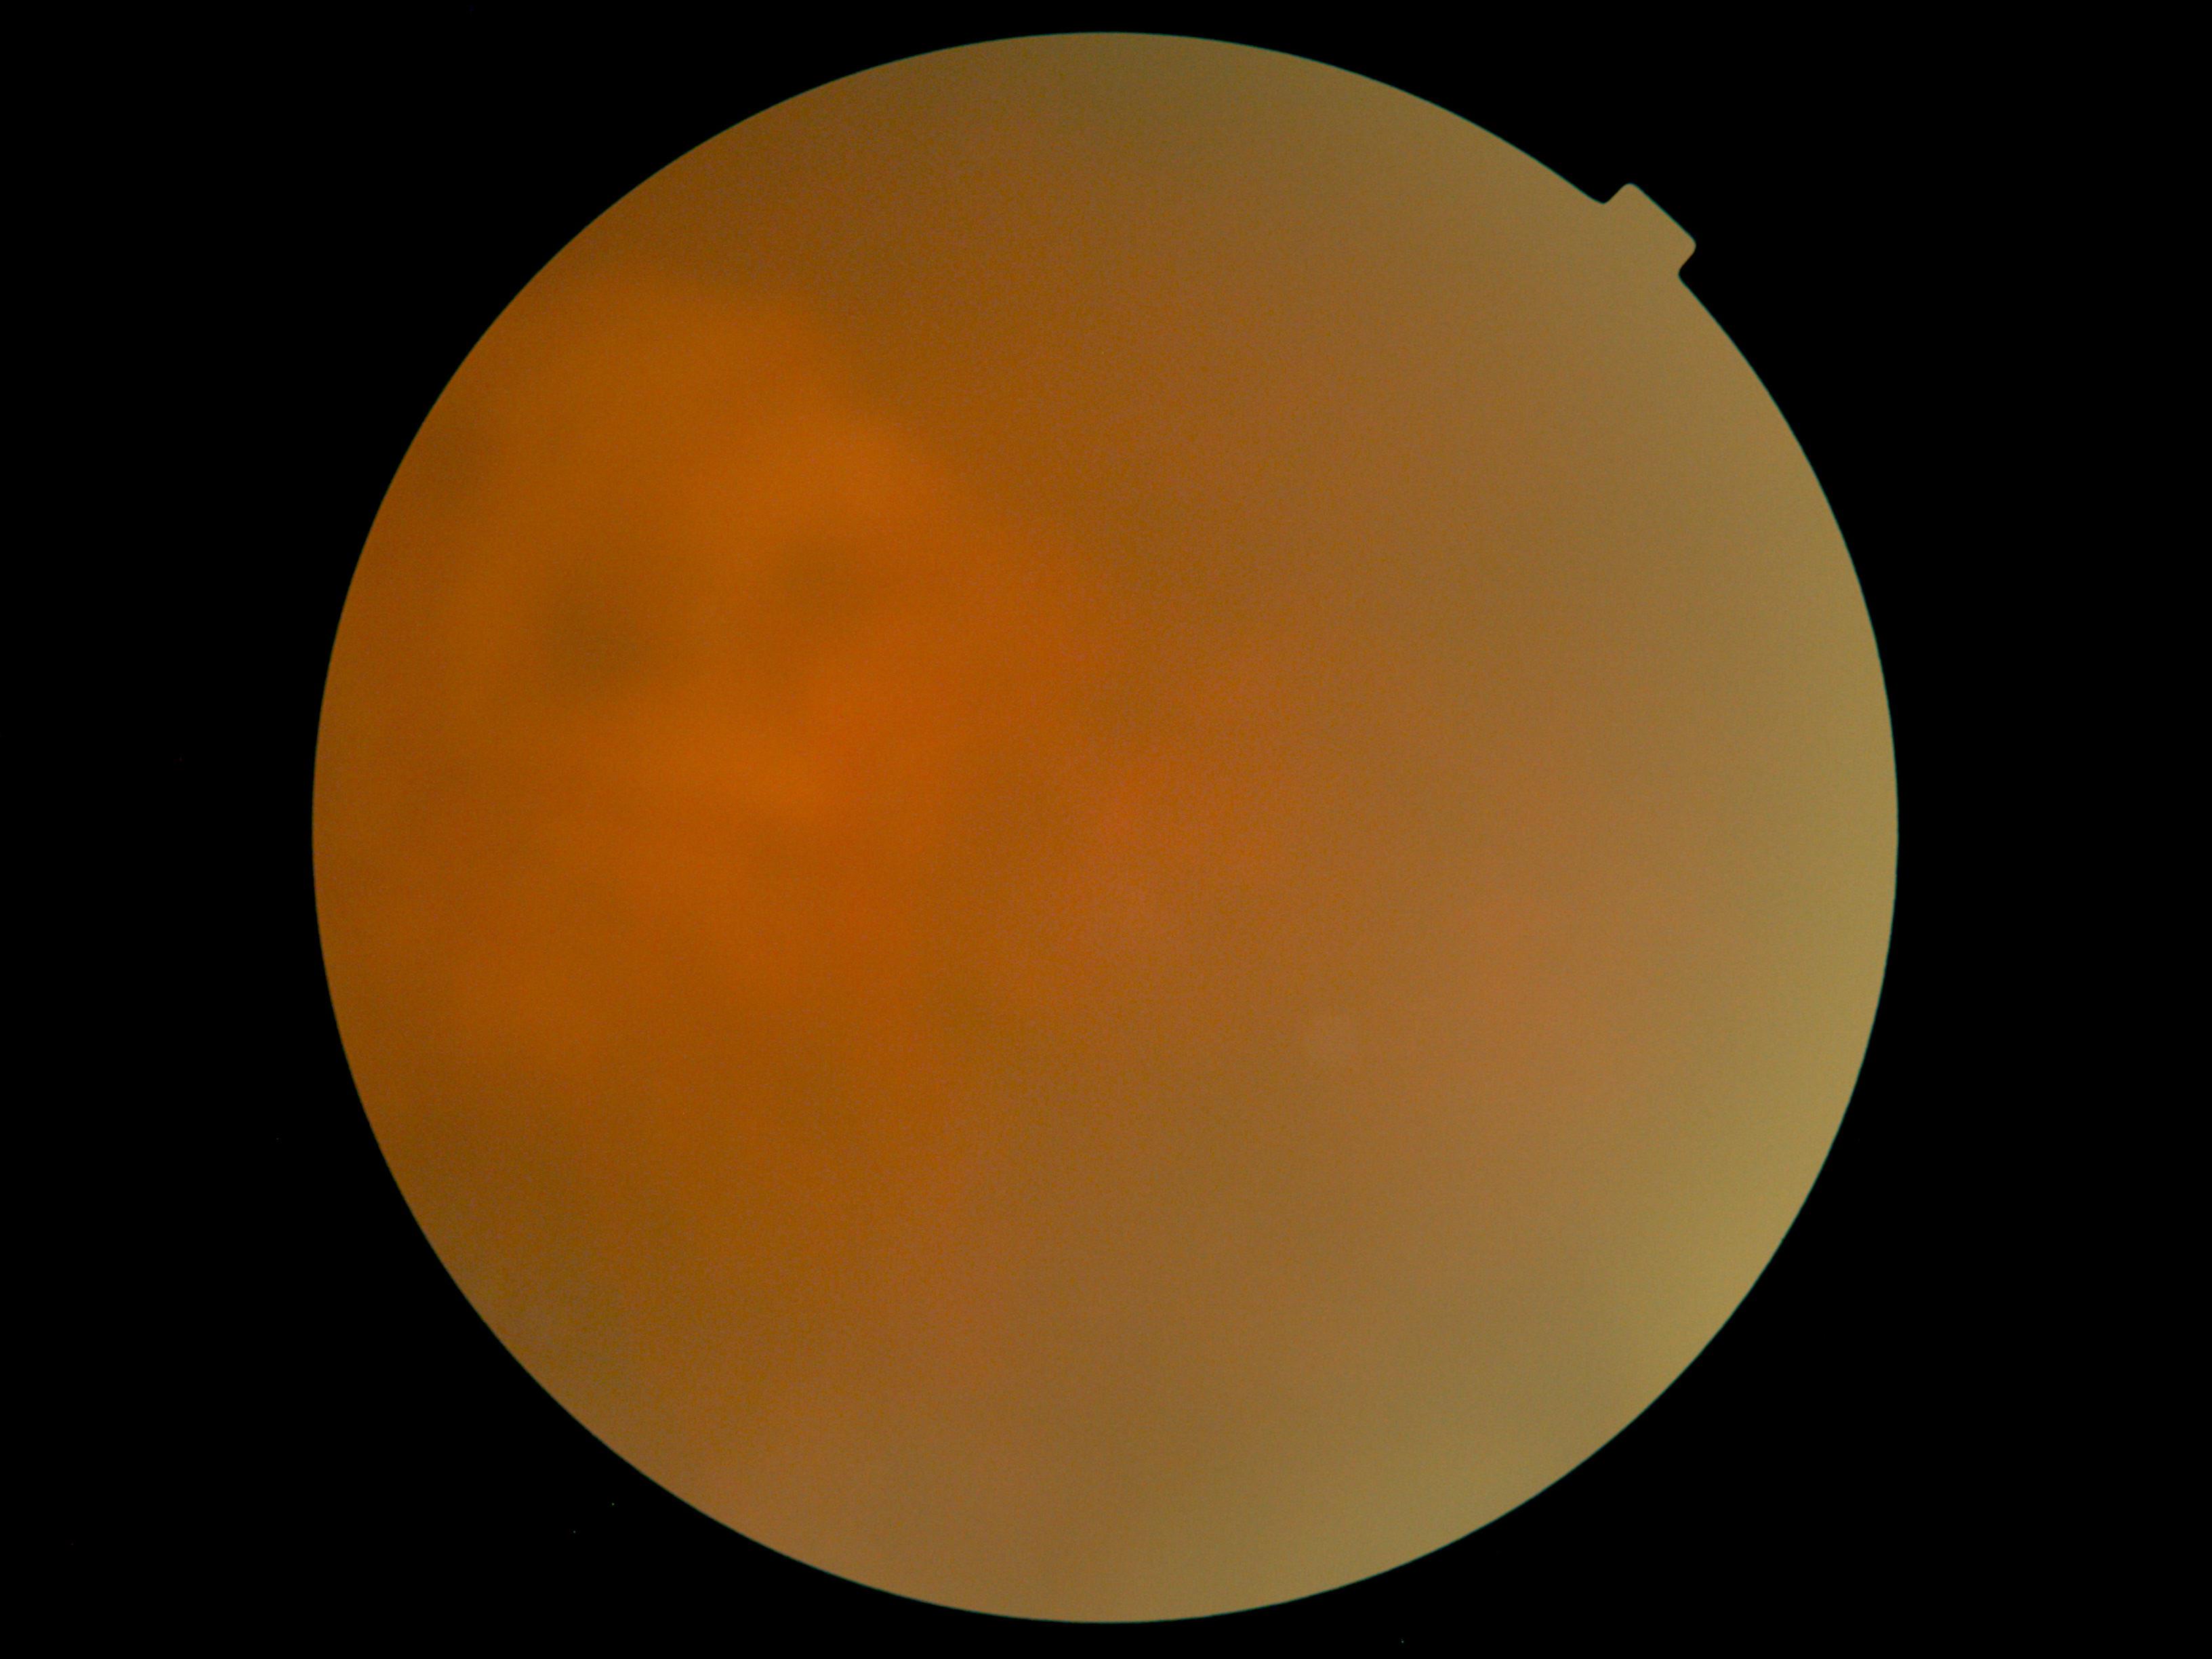
The image cannot be graded for diabetic retinopathy. Diabetic retinopathy severity is ungradable.